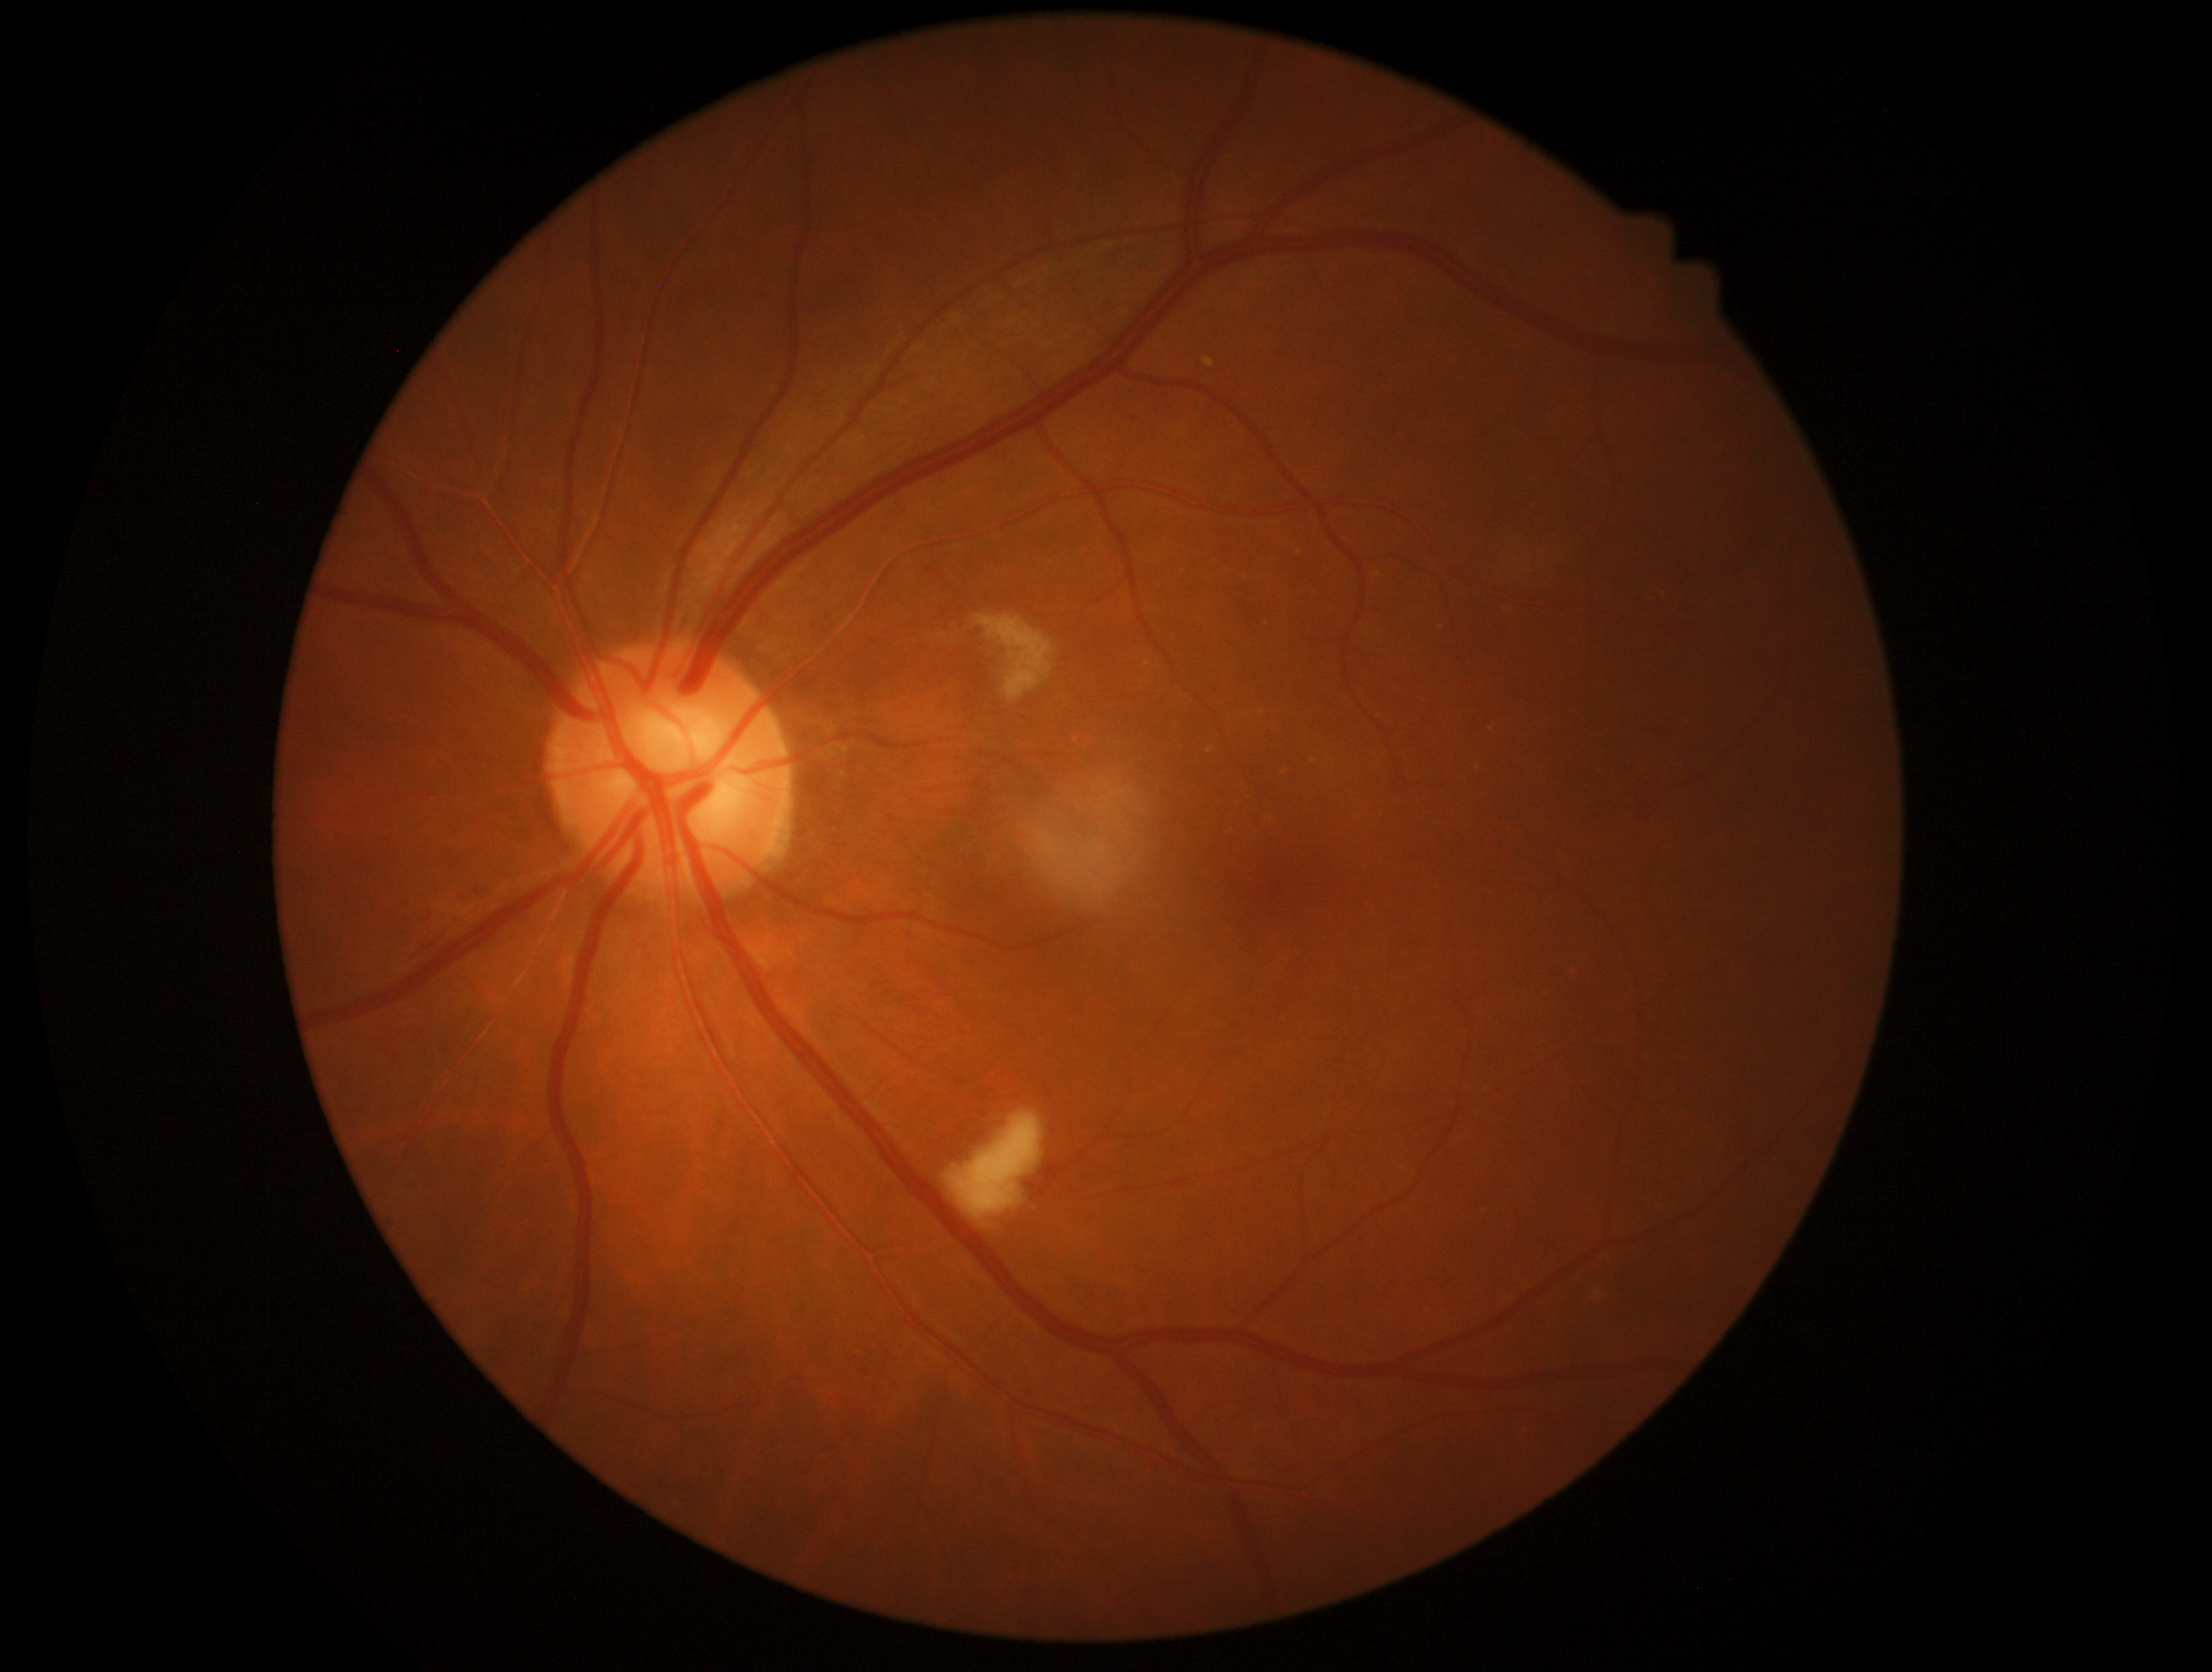 Diabetic retinopathy severity: grade 2 (moderate NPDR).